45-degree field of view:
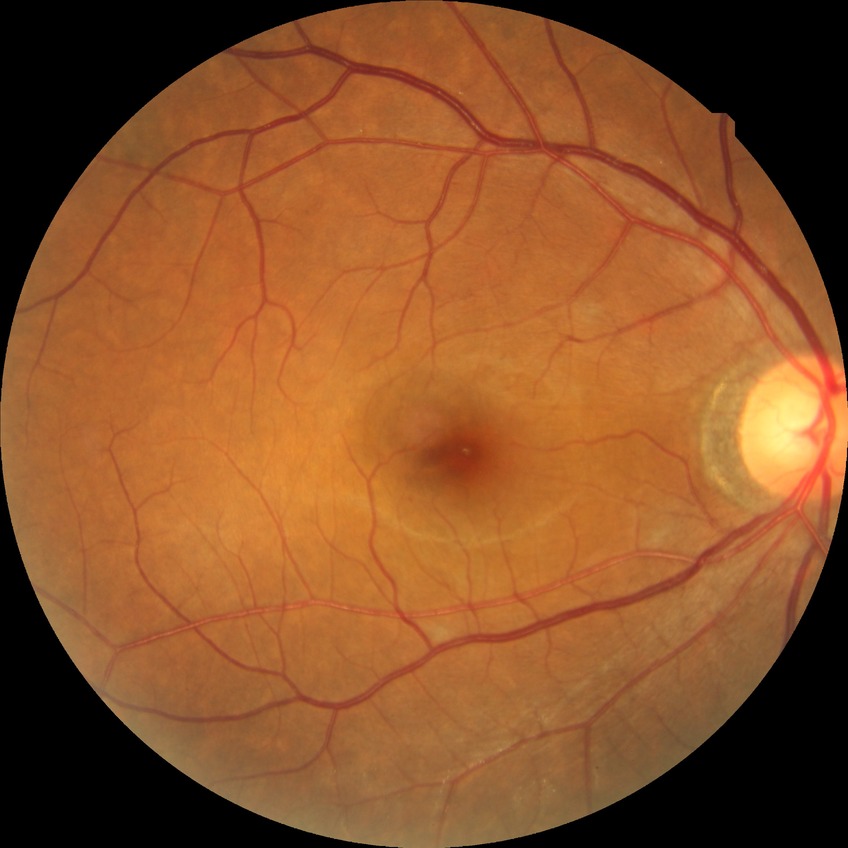
Retinopathy stage: no diabetic retinopathy.